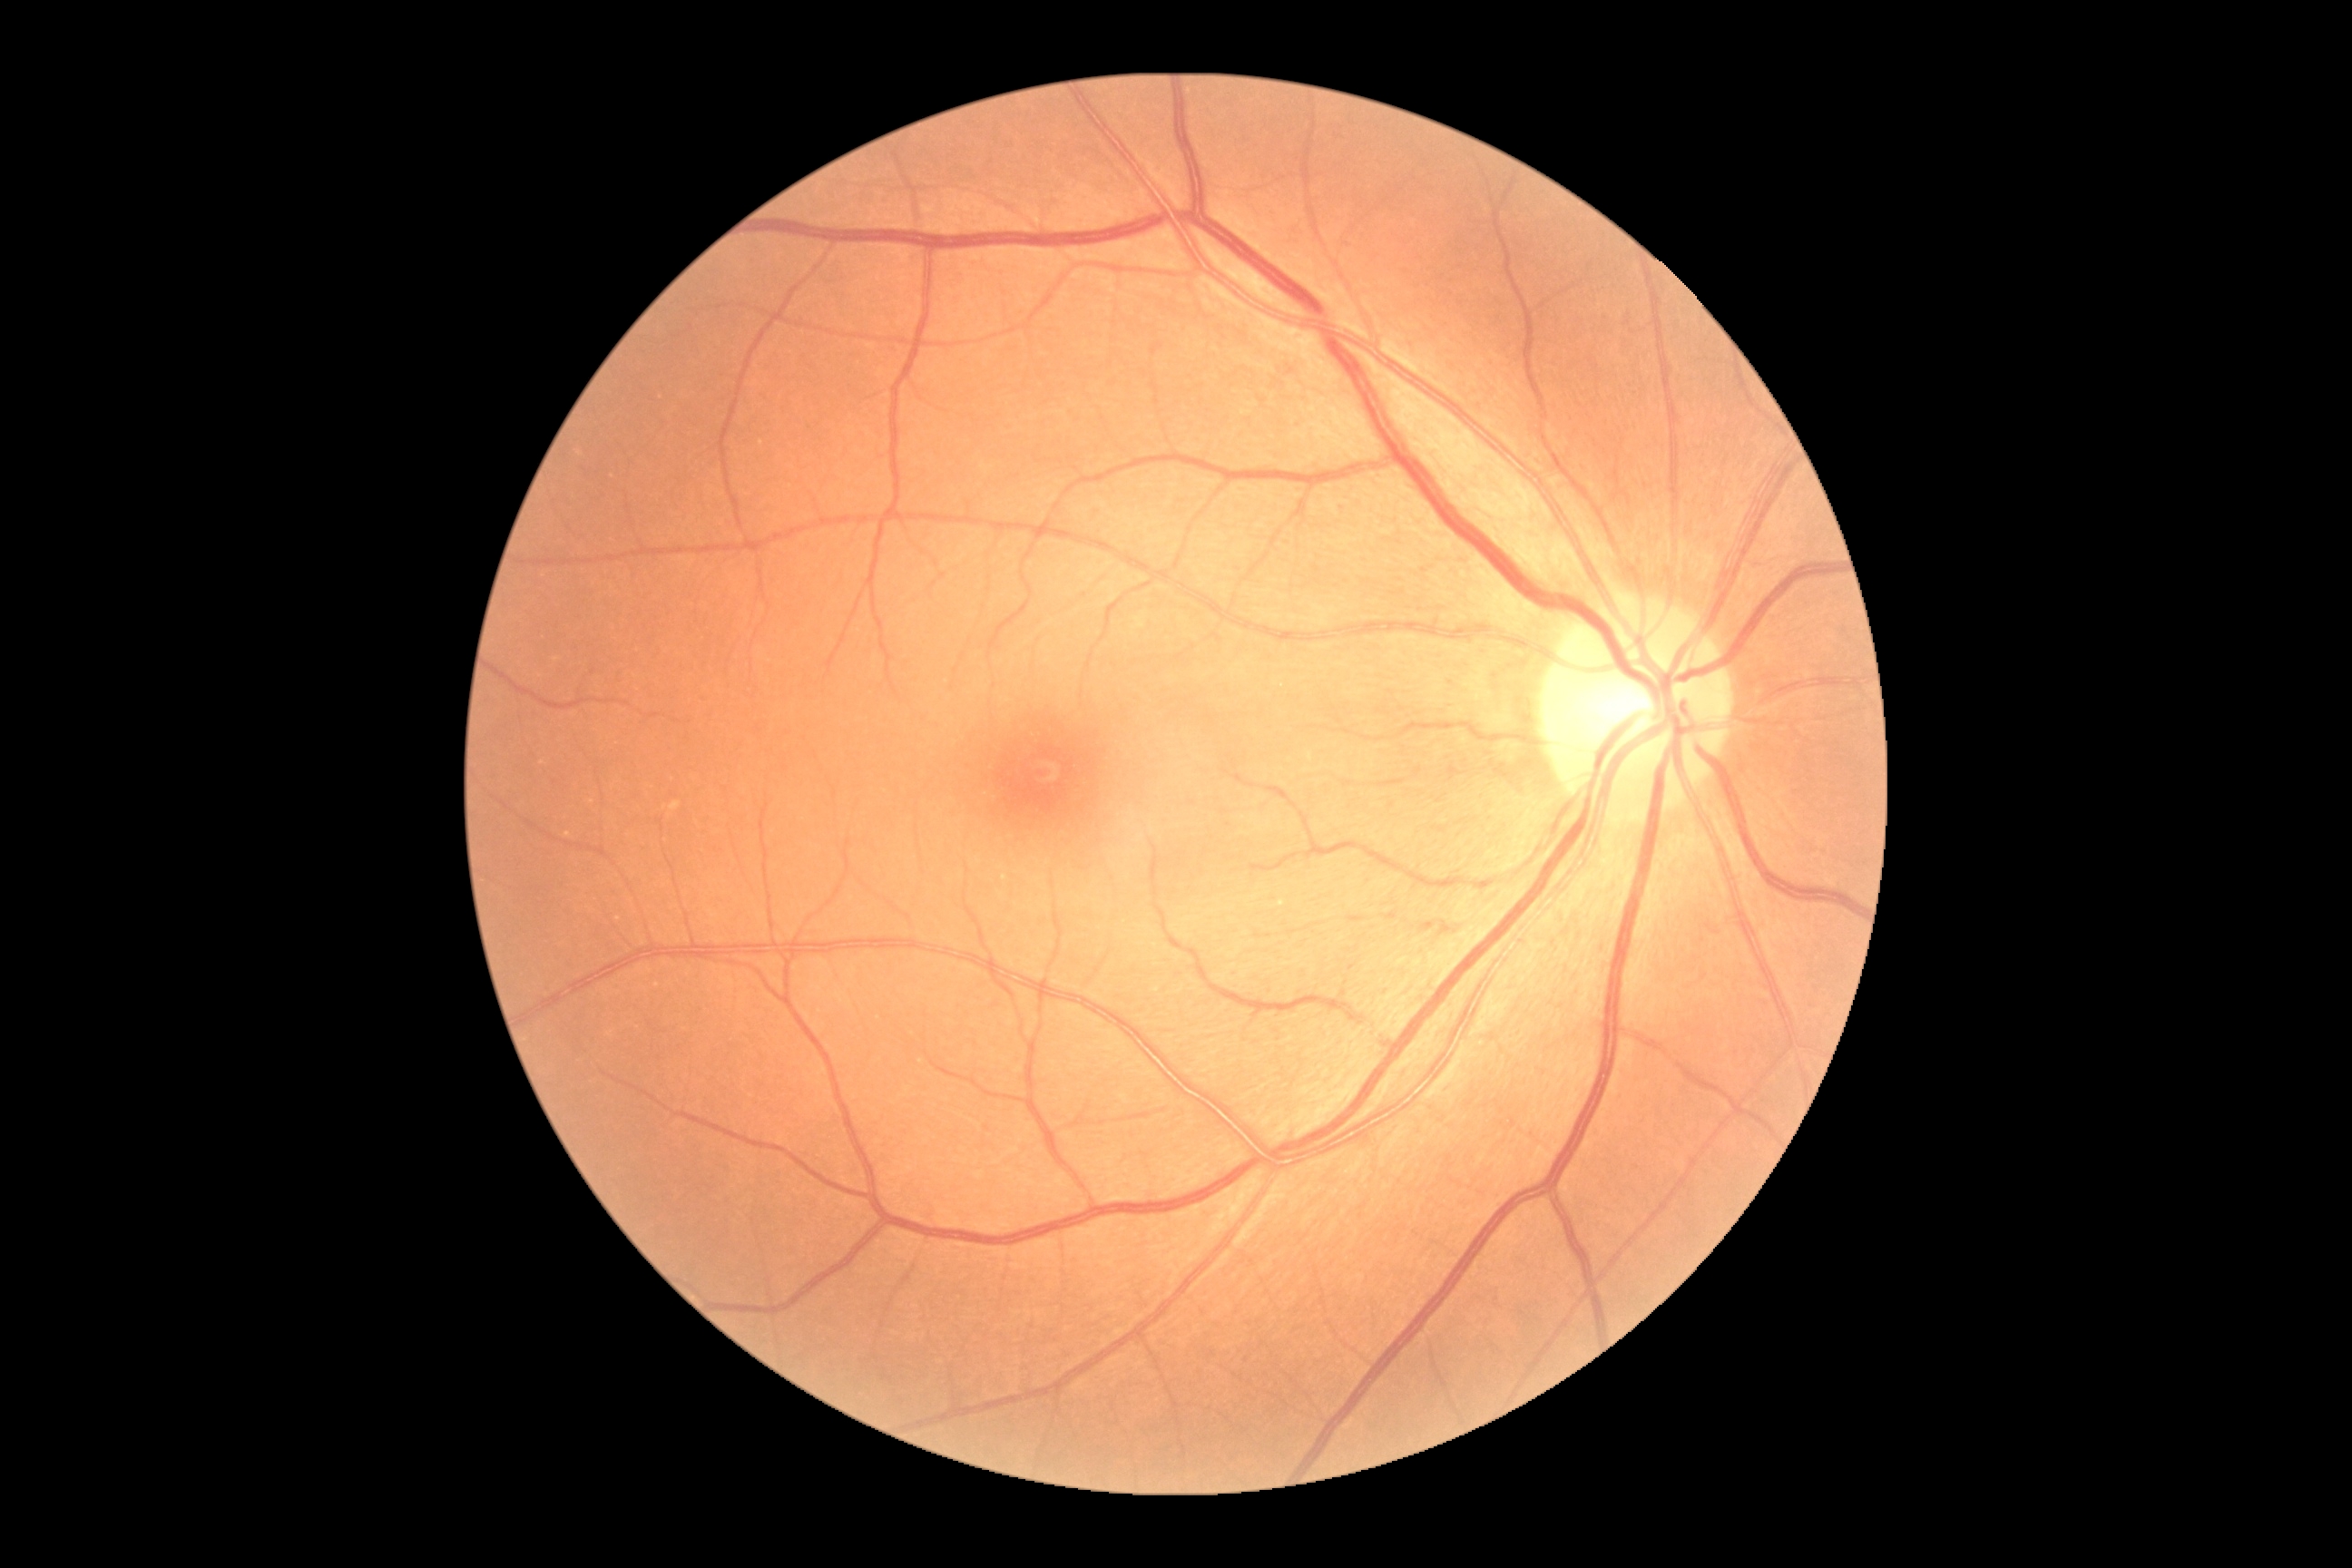 DR severity=grade 0 (no apparent retinopathy).